Wide-field fundus photograph from neonatal ROP screening · 1240 by 1240 pixels:
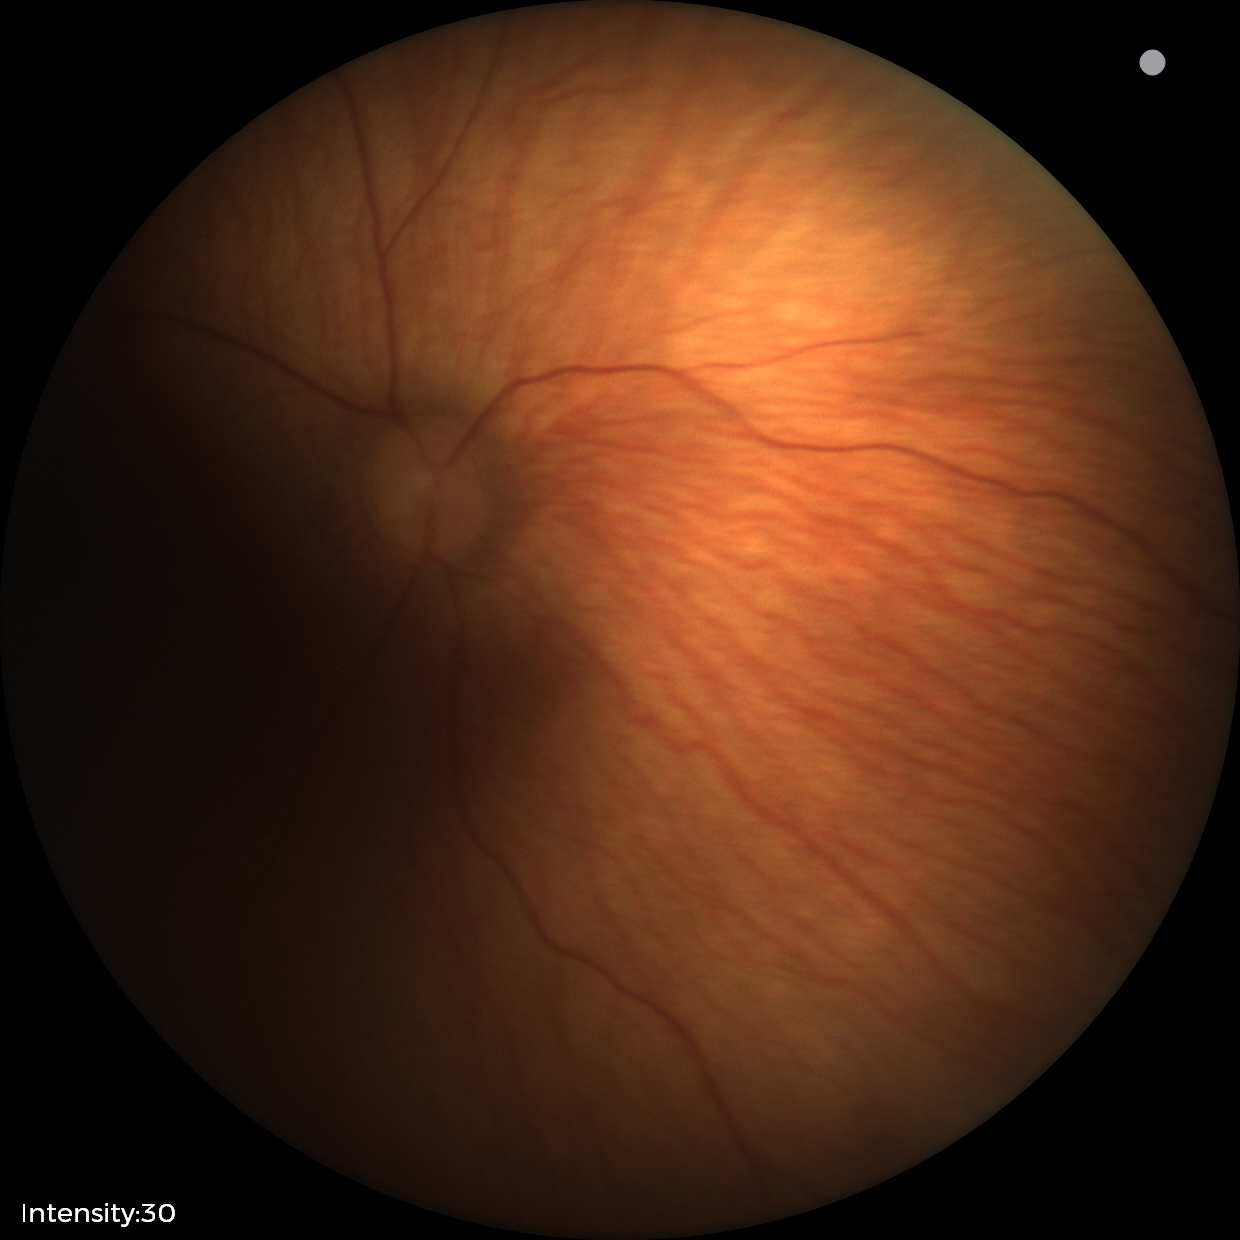
Physiological retinal appearance for postconceptual age.